848 x 848 pixels · 45° FOV · no pharmacologic dilation · acquired with a NIDEK AFC-230 · color fundus photograph:
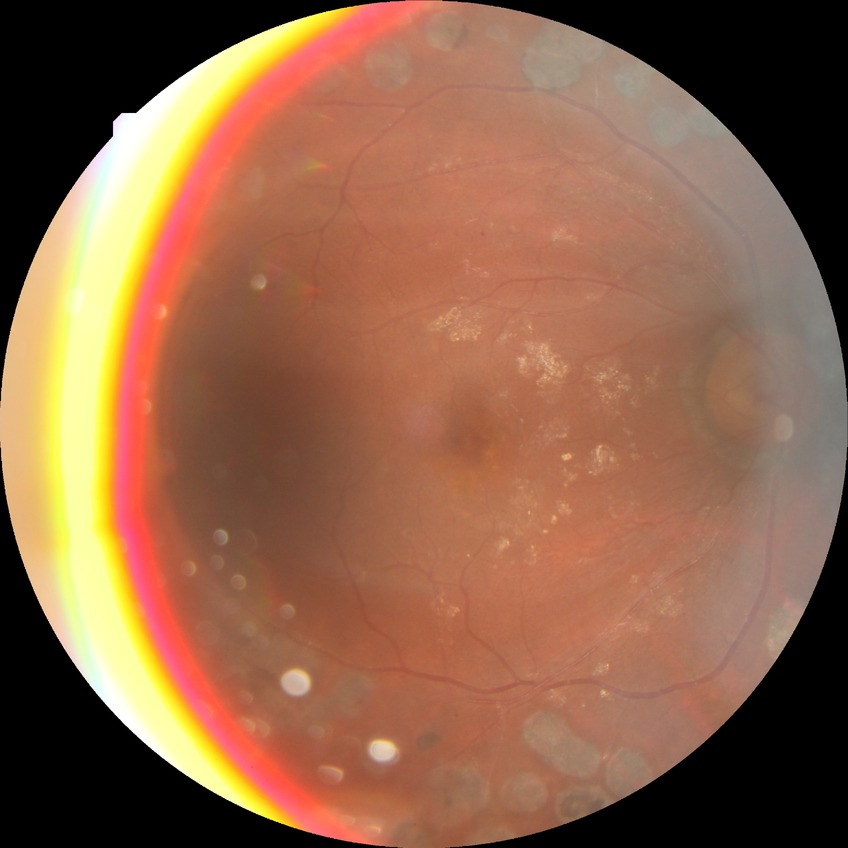 Davis DR grade is PDR.